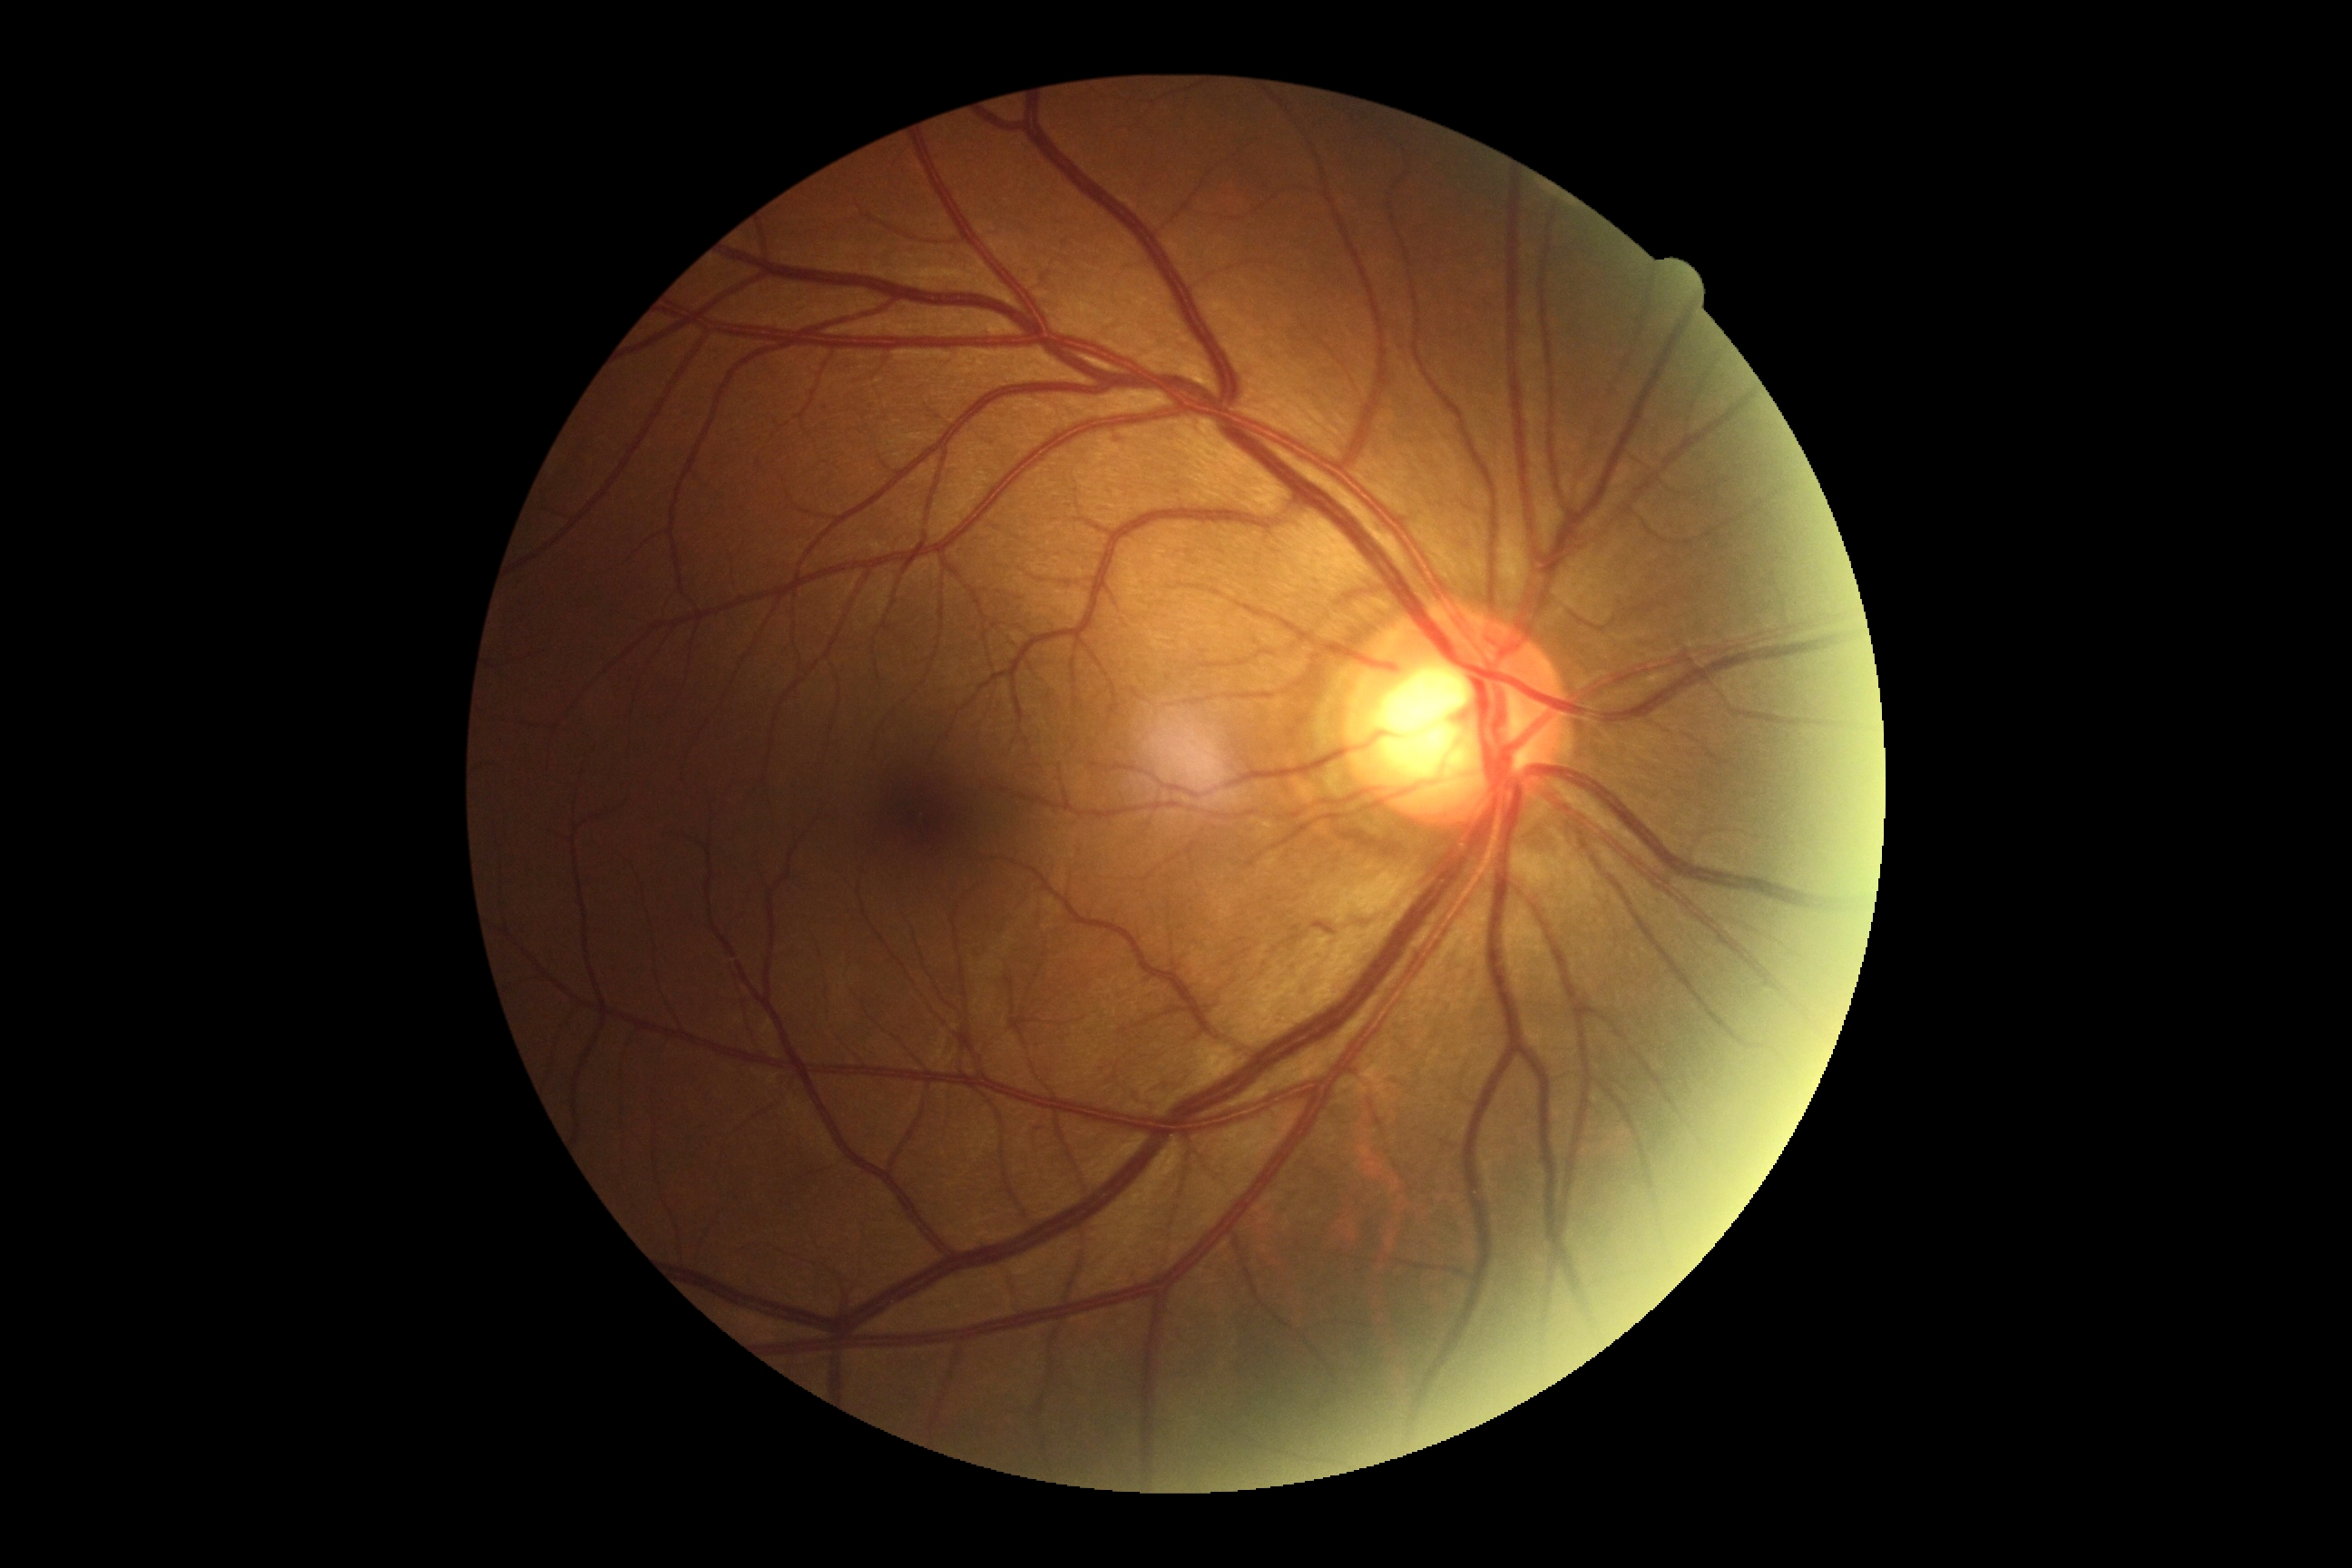 retinopathy grade: no apparent retinopathy (0).